UWF retinal mosaic — 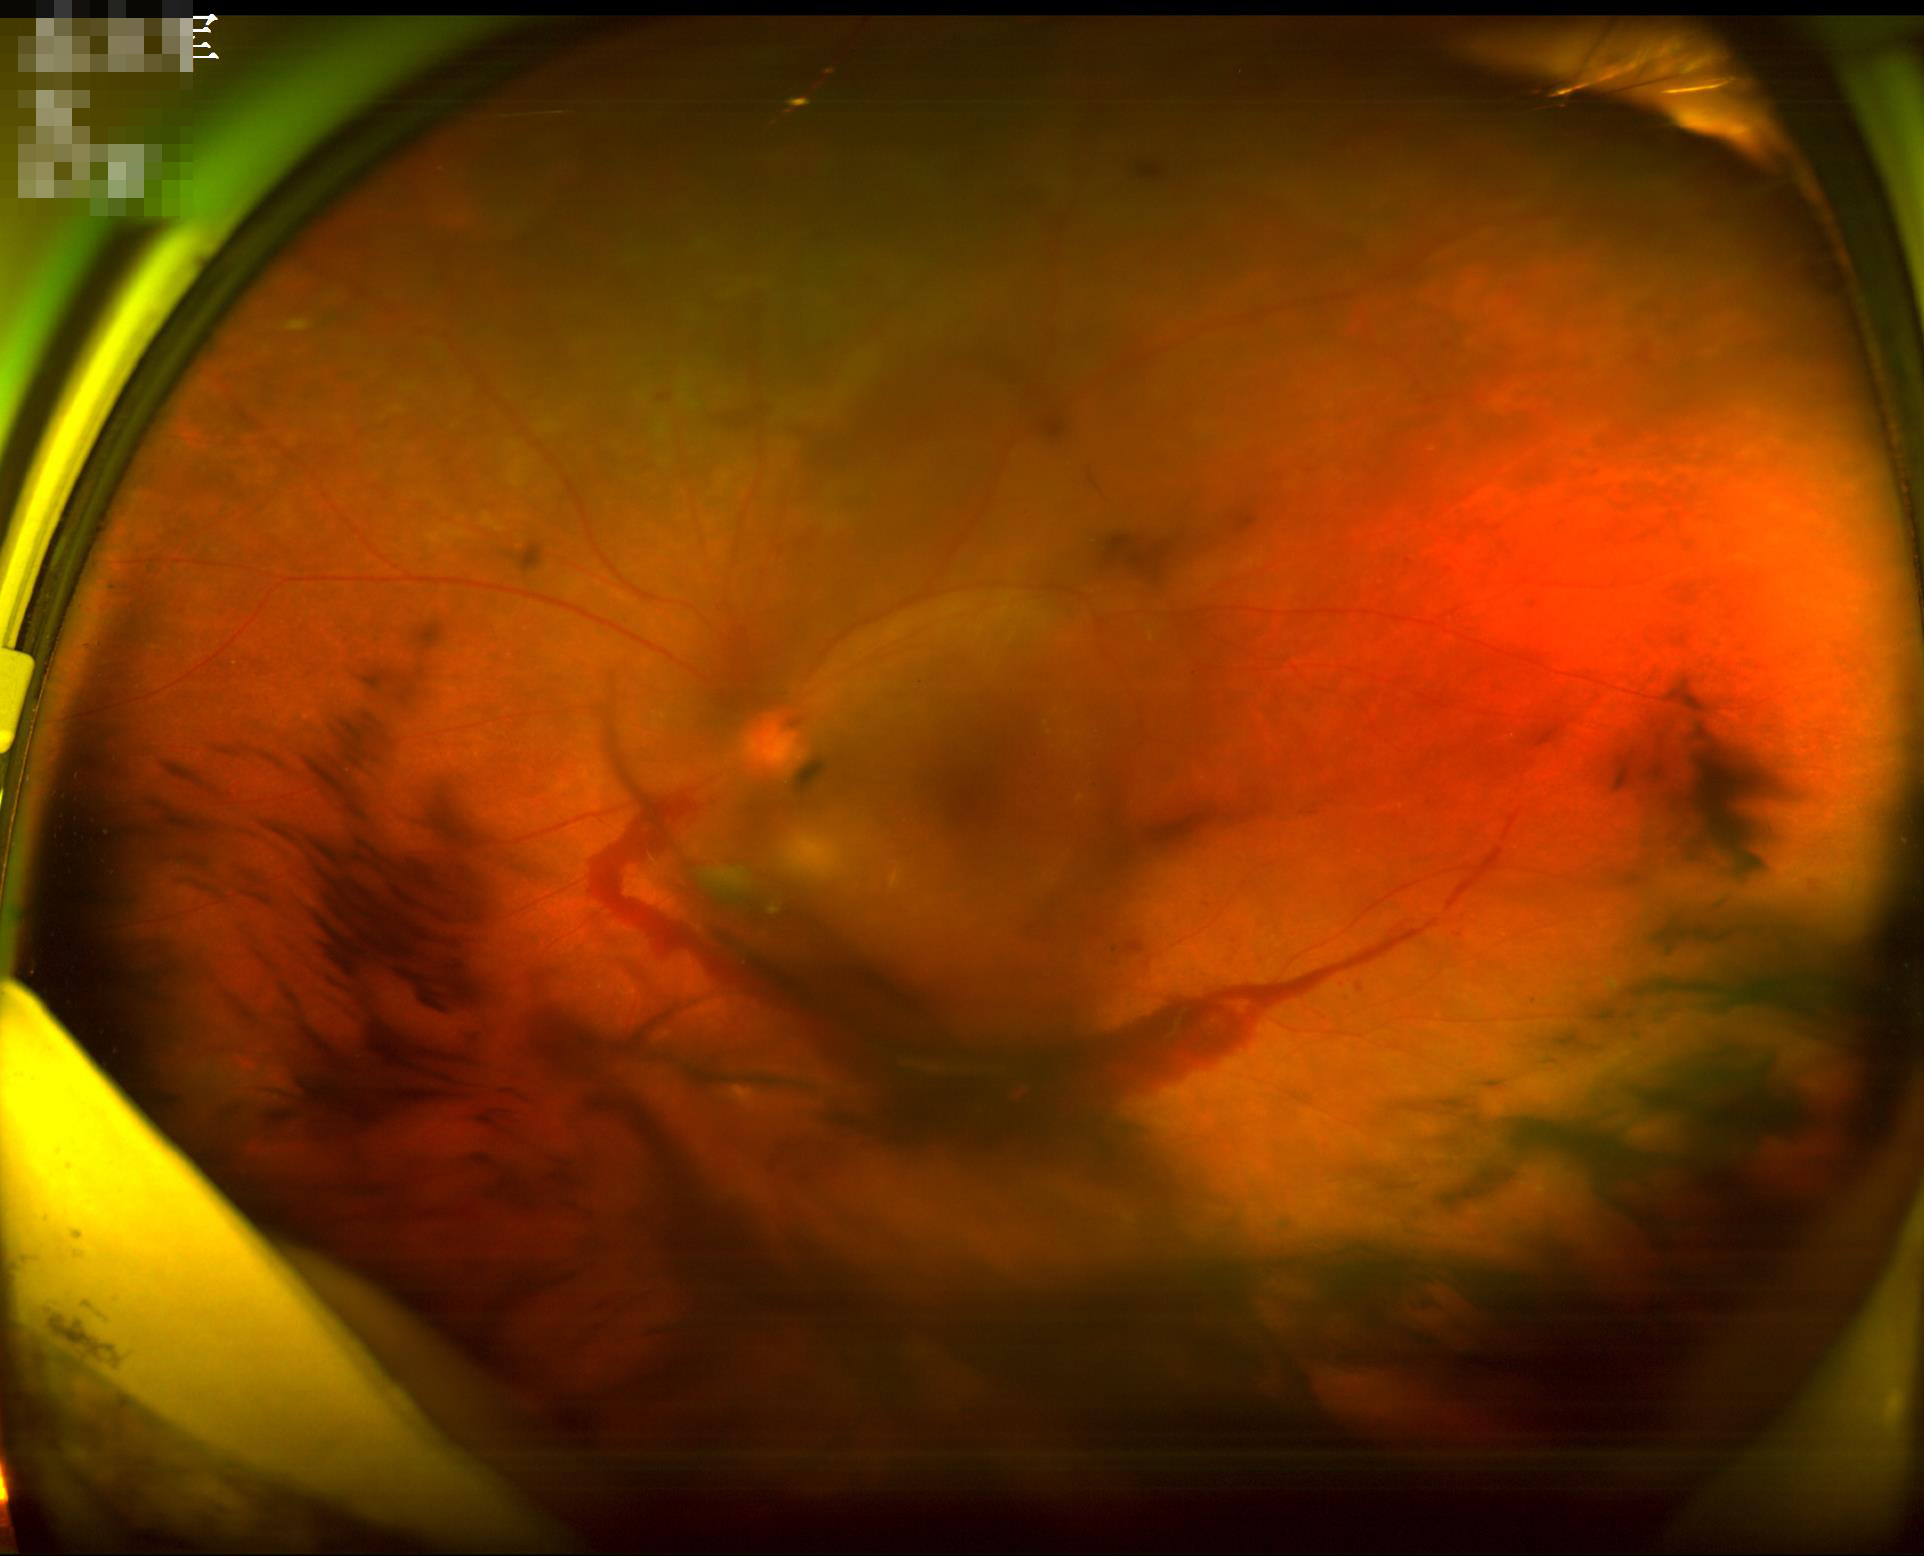
Noticeable blur in the optic disc, vessels, or background. Image quality is suboptimal. Illumination and color are suboptimal. Contrast is low.